RetCam wide-field infant fundus image.
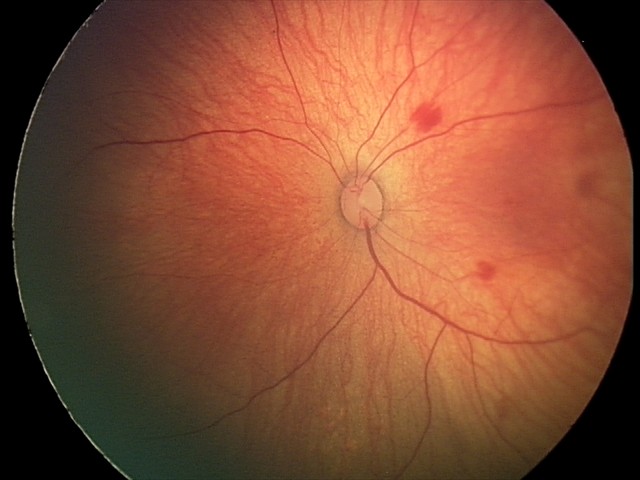
Screening series with retinal hemorrhages.